Color fundus image. NIDEK AFC-230: 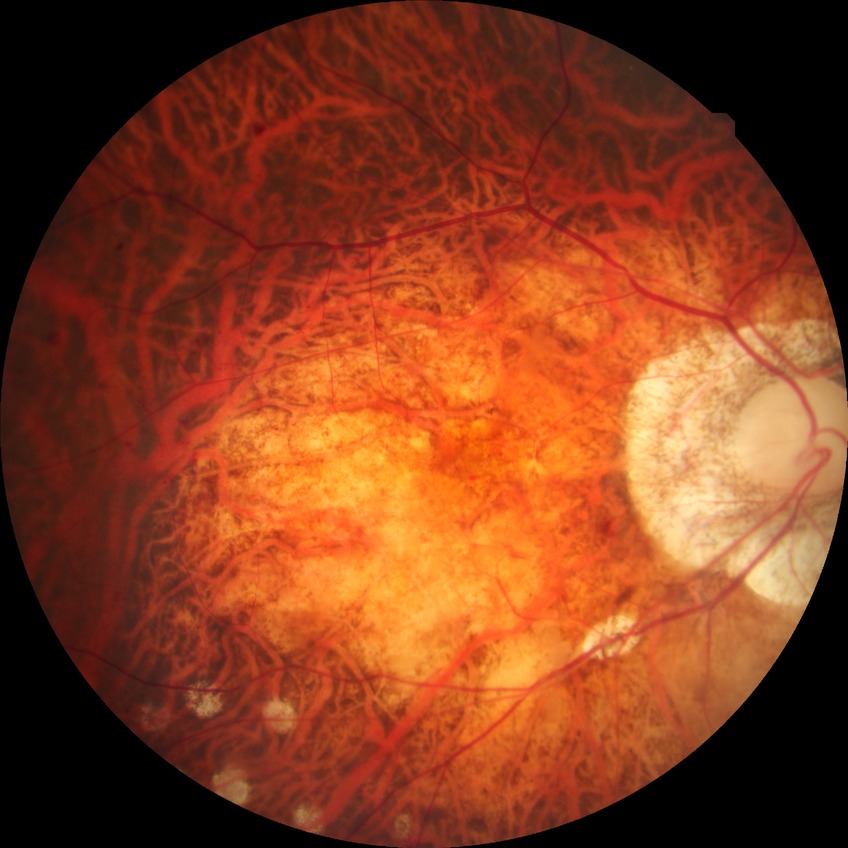 Davis grade: PDR.